Camera: Phoenix ICON (100° FOV) · wide-field contact fundus photograph of an infant · 1240 by 1240 pixels:
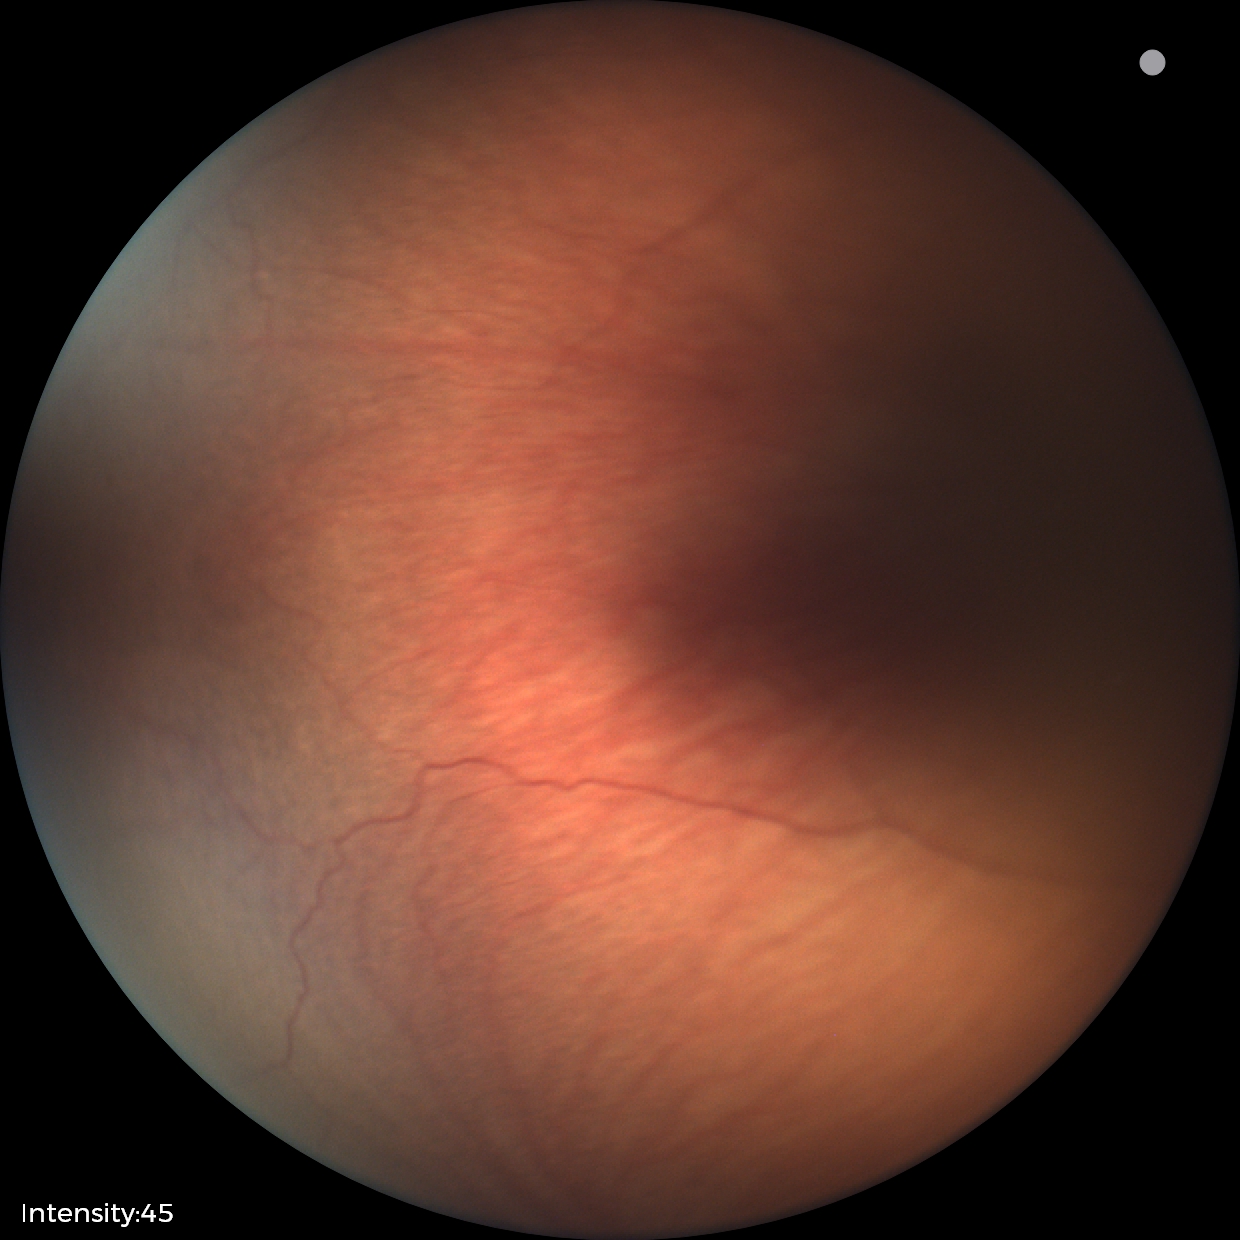

Plus disease absent. Diagnosis from this screening exam: status post retinopathy of prematurity (ROP).